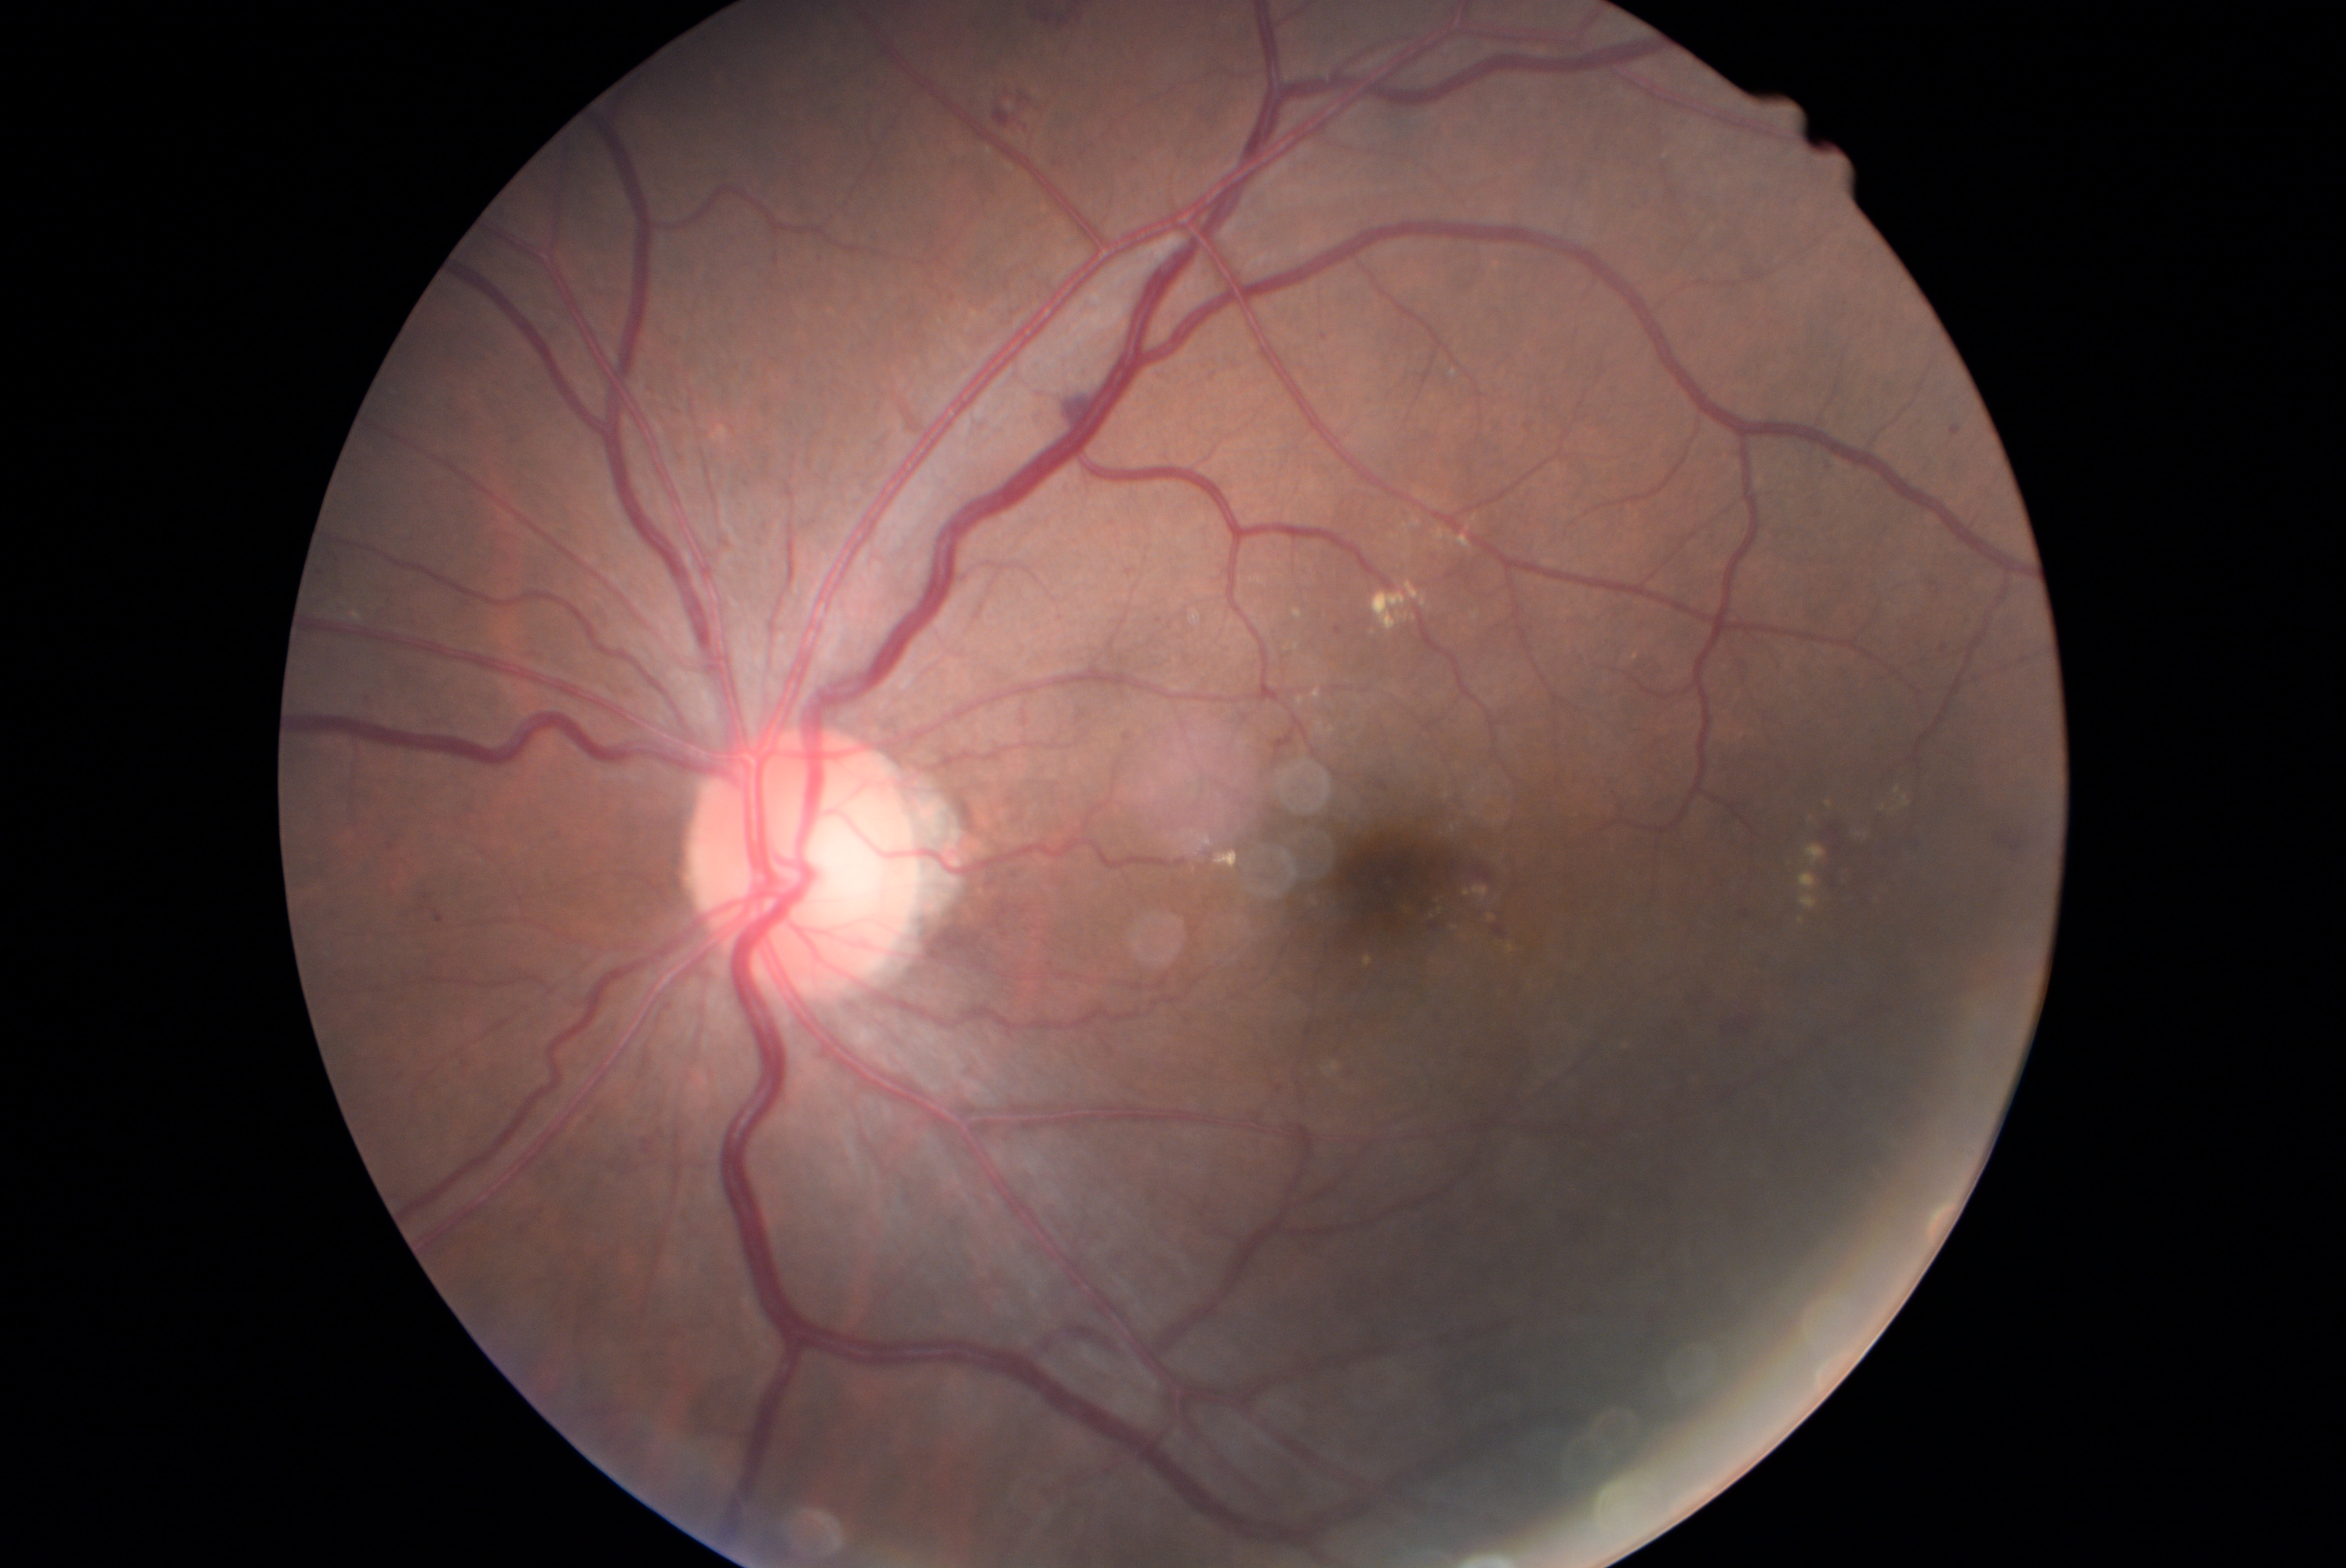 DR grade: moderate non-proliferative diabetic retinopathy (2).